1924 x 1556 pixels; 50-degree field of view: 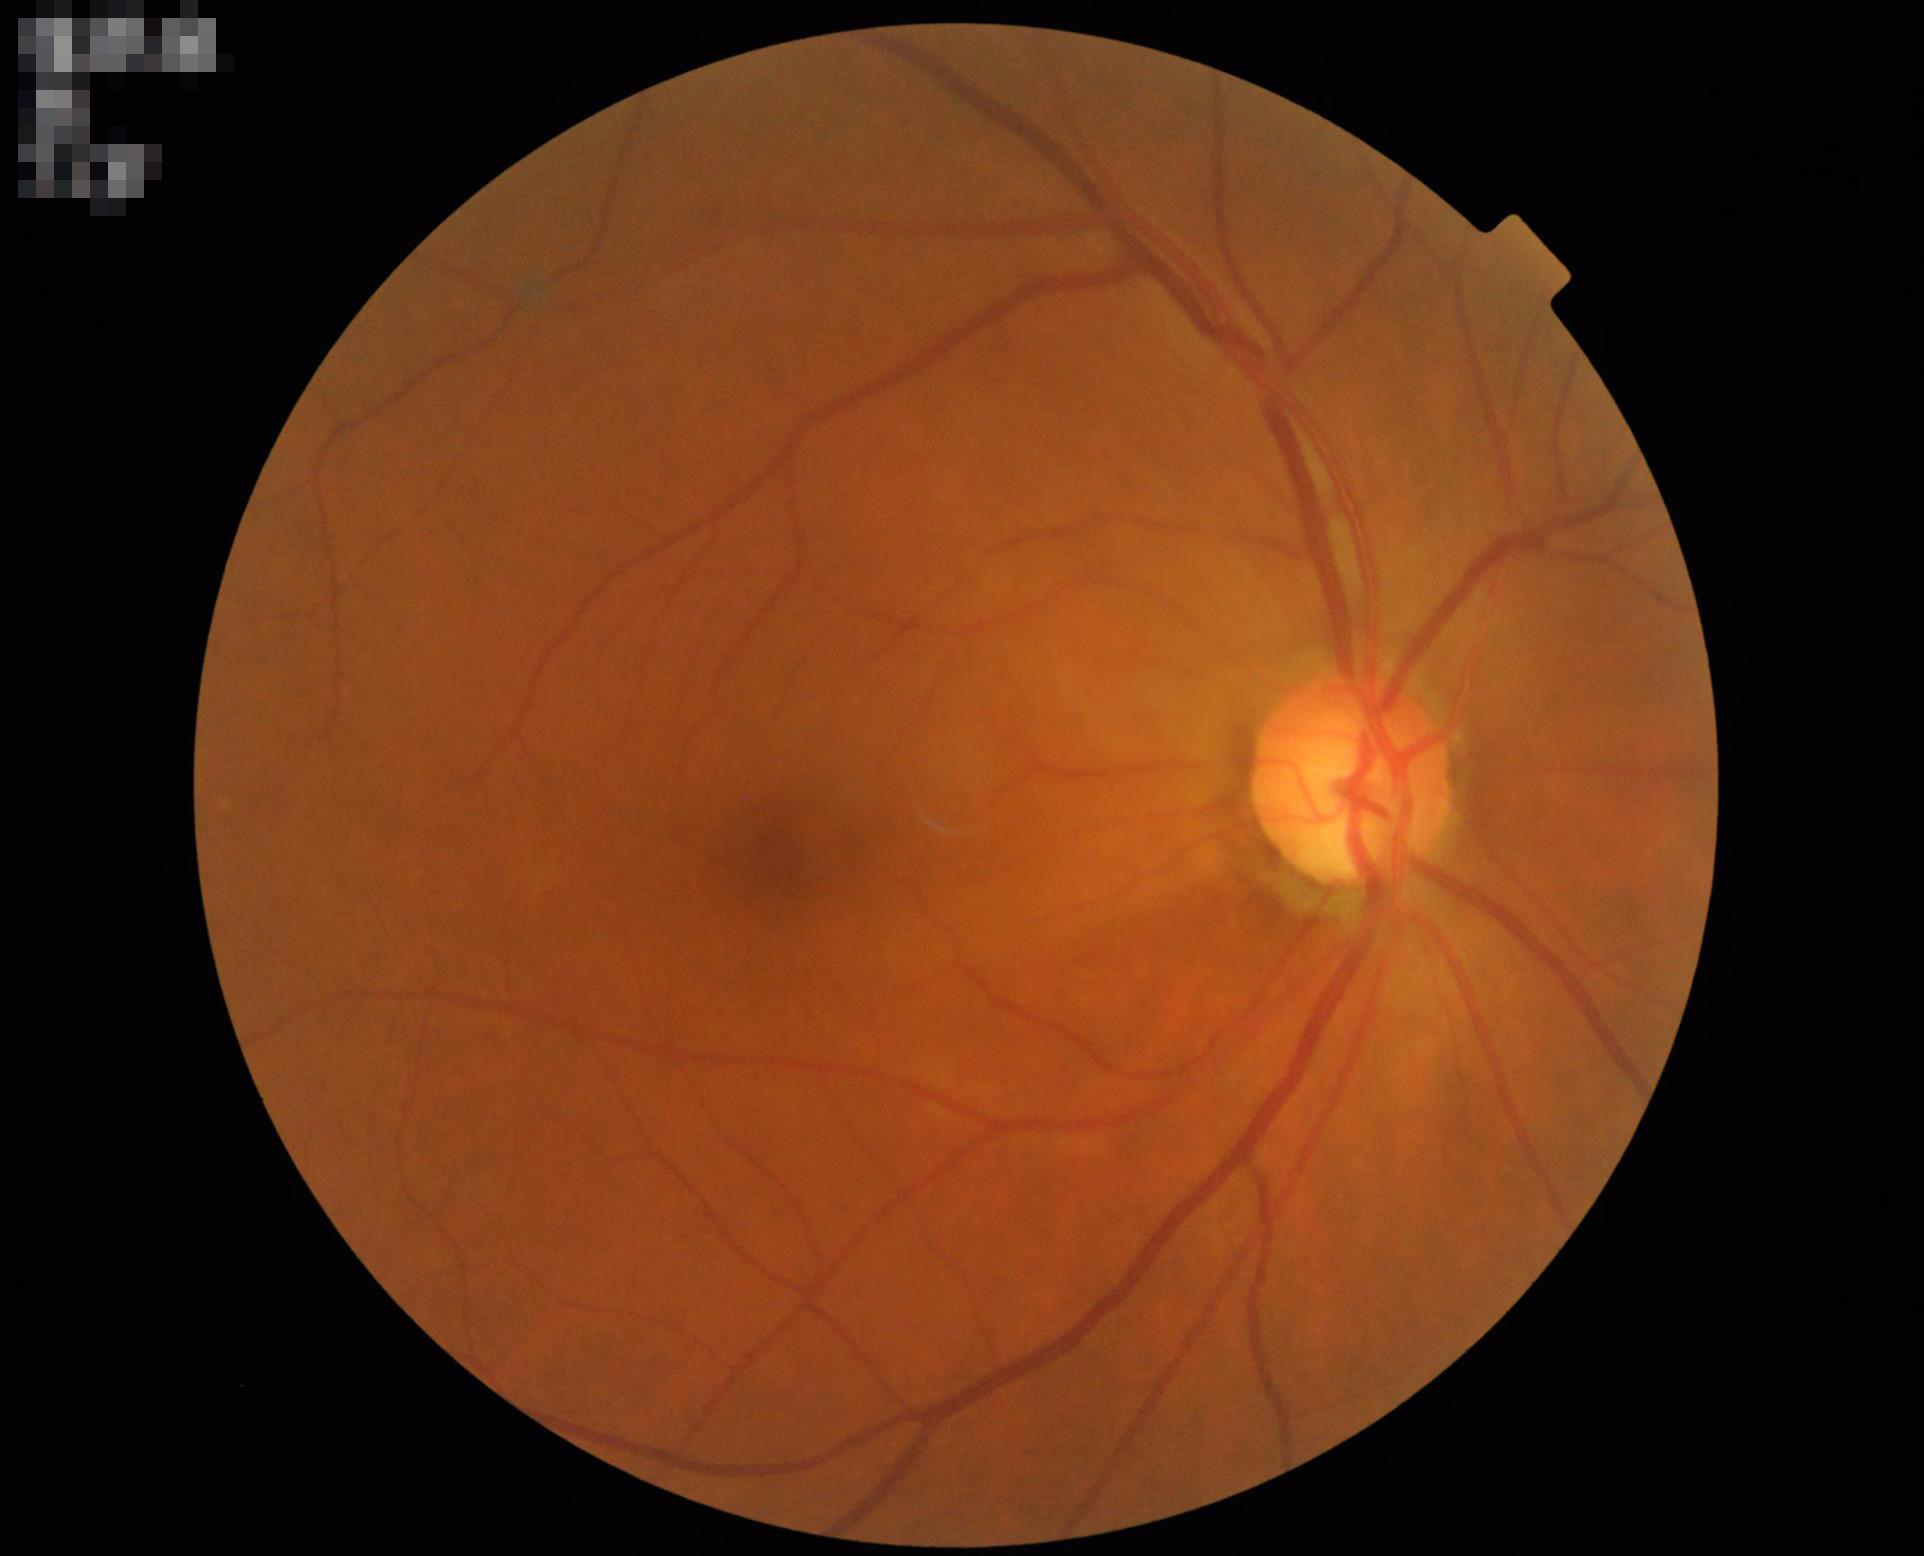 No over- or under-exposure.
Vessels and details are readily distinguishable.
Overall image quality is good.
The image is clear.